Topcon TRC-NW8 — 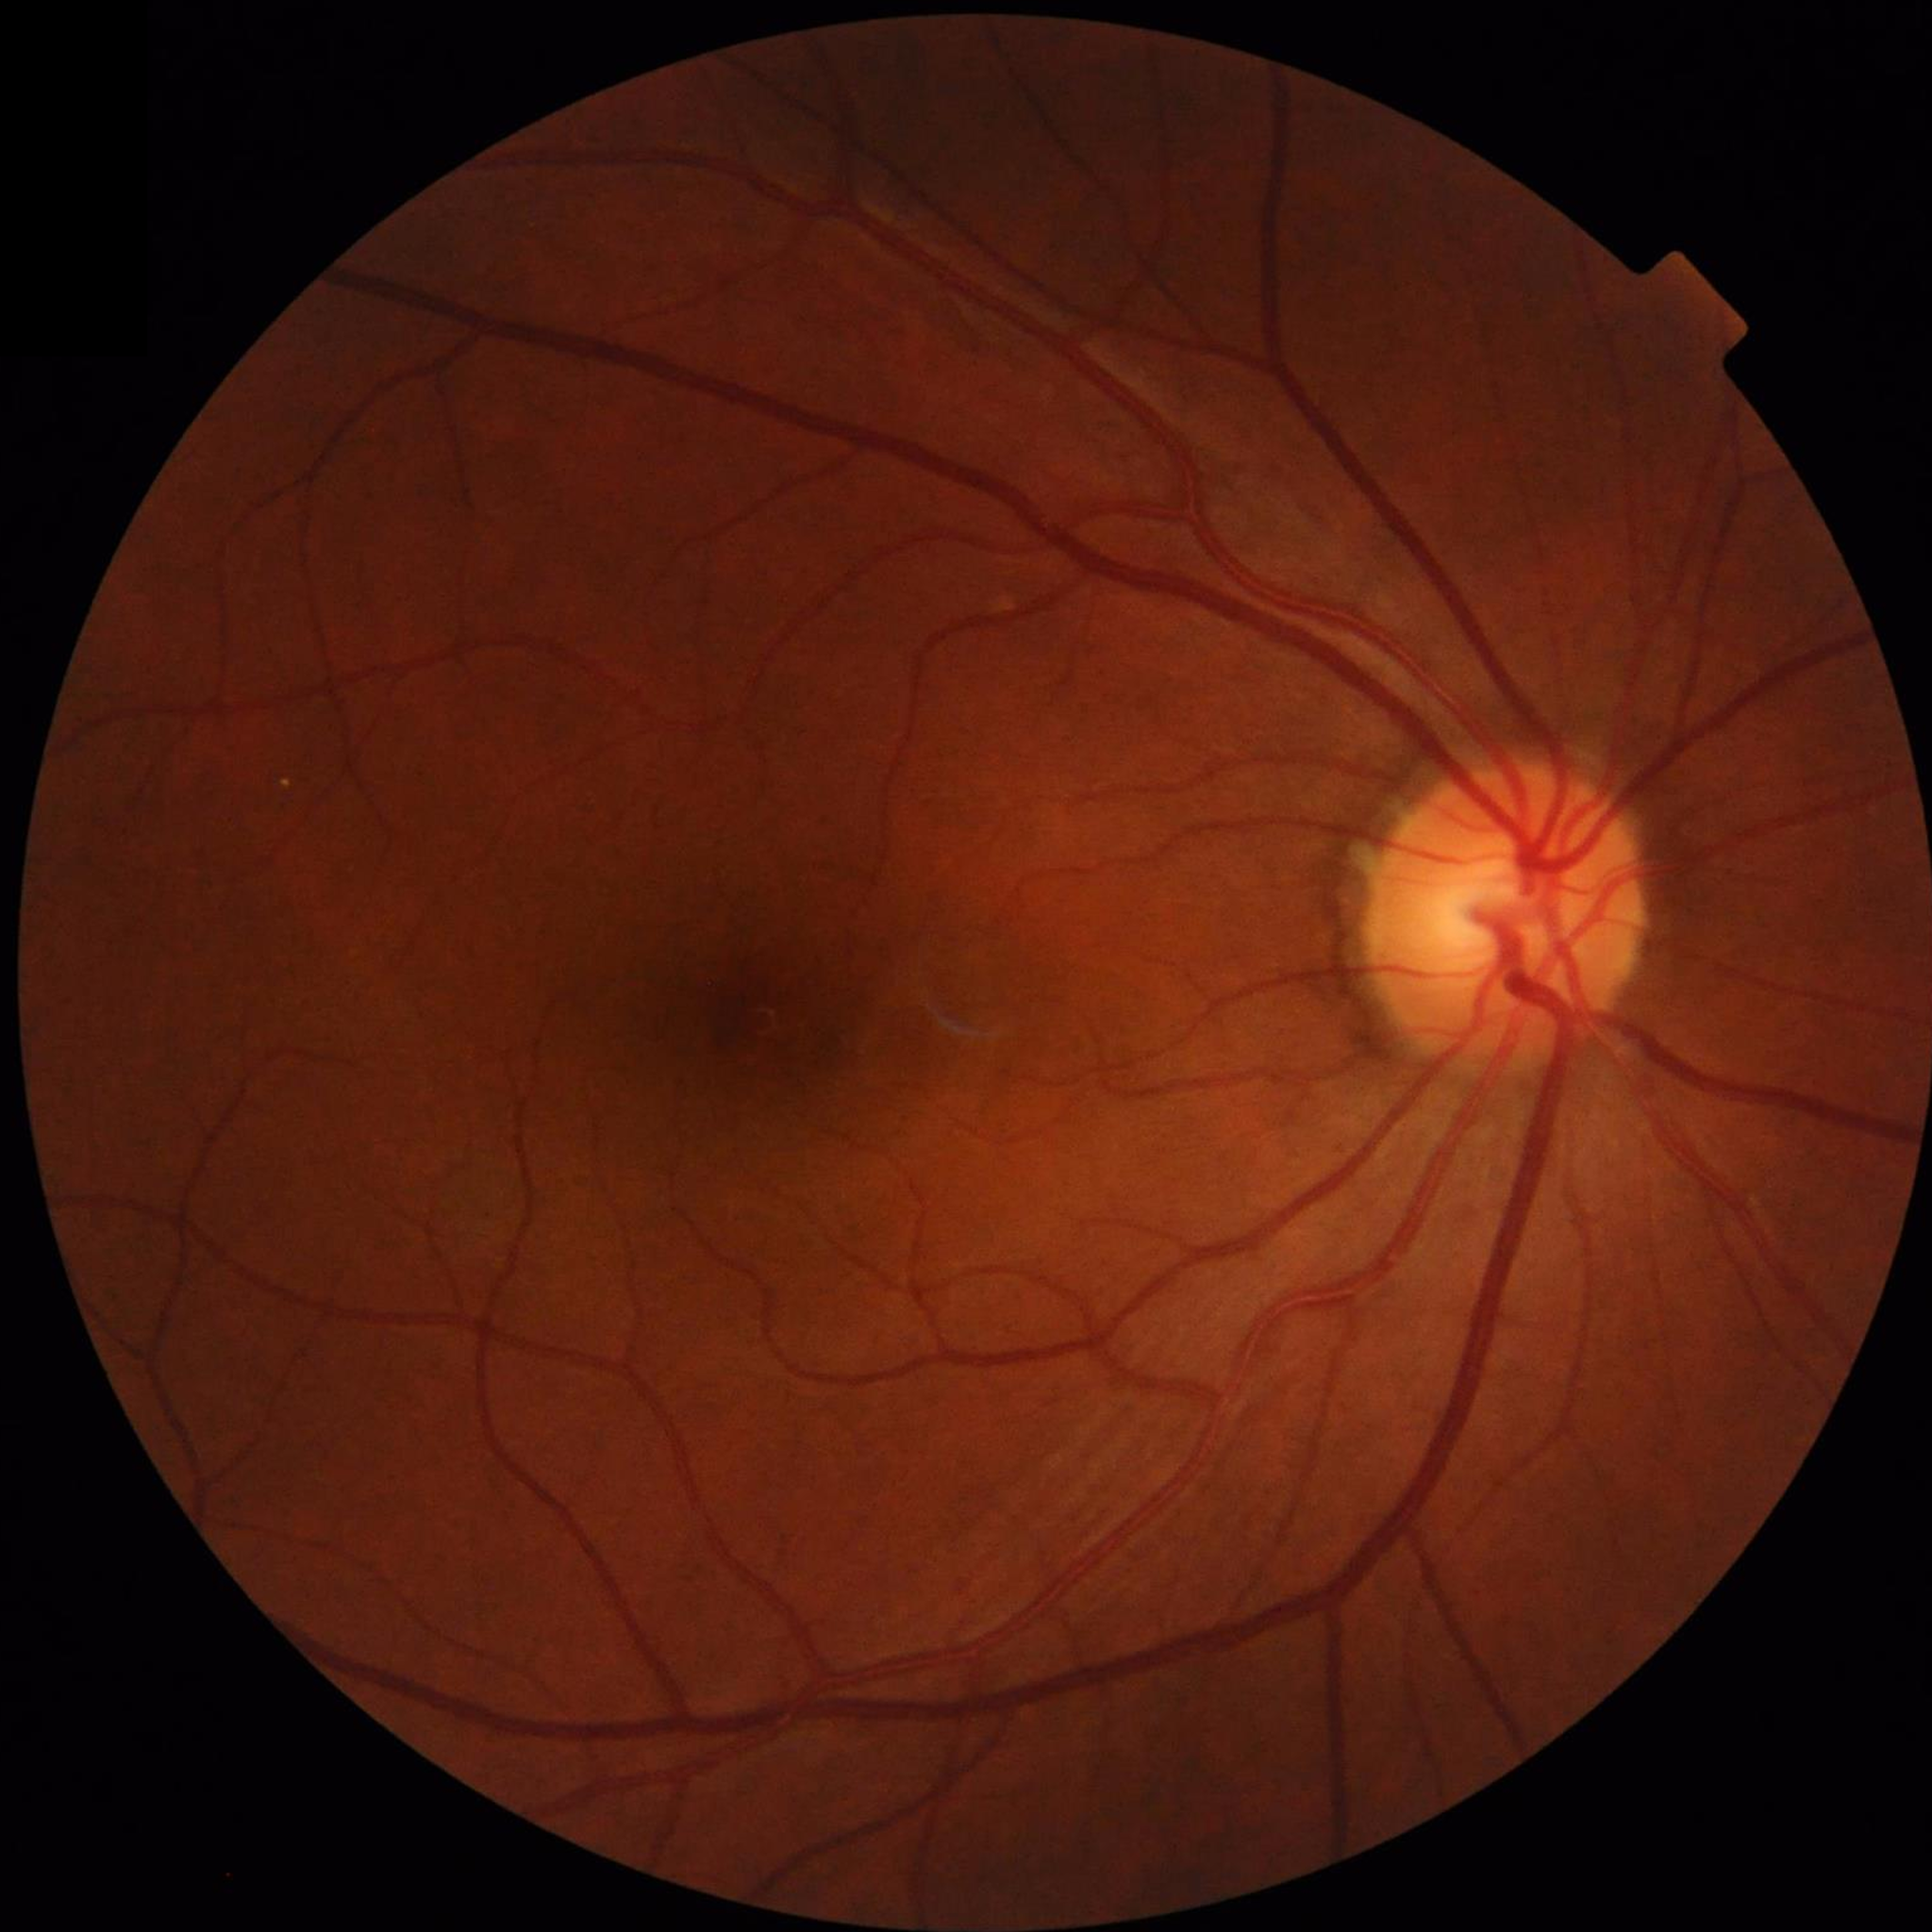

Diagnosis: no AMD, DR, or glaucomatous findings.